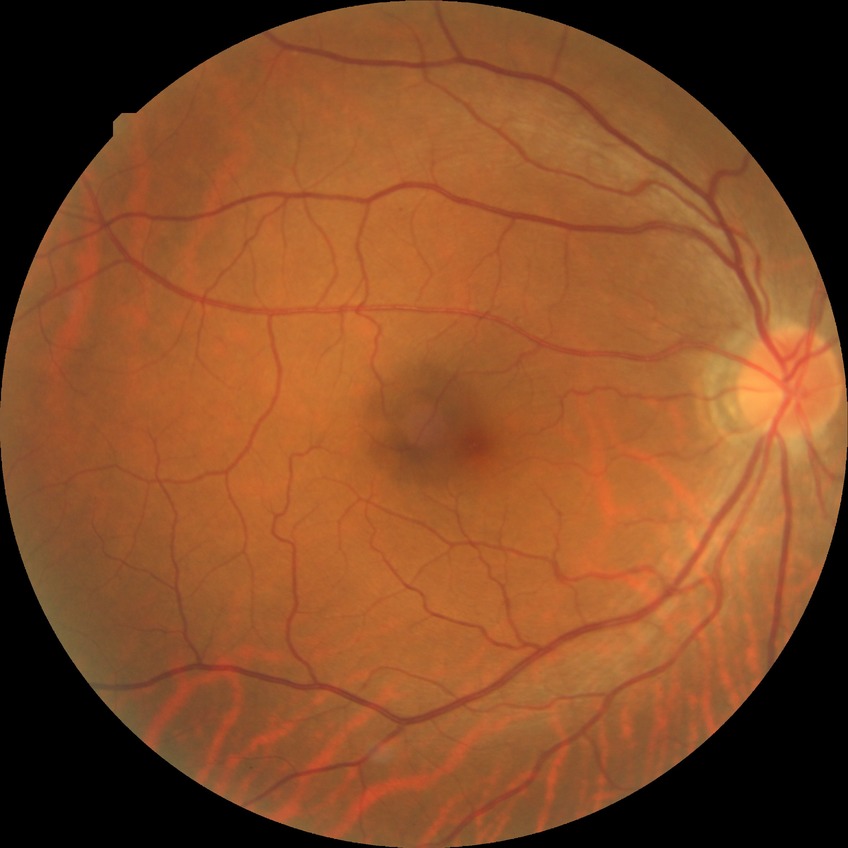 Diabetic retinopathy (DR) is NDR (no diabetic retinopathy).